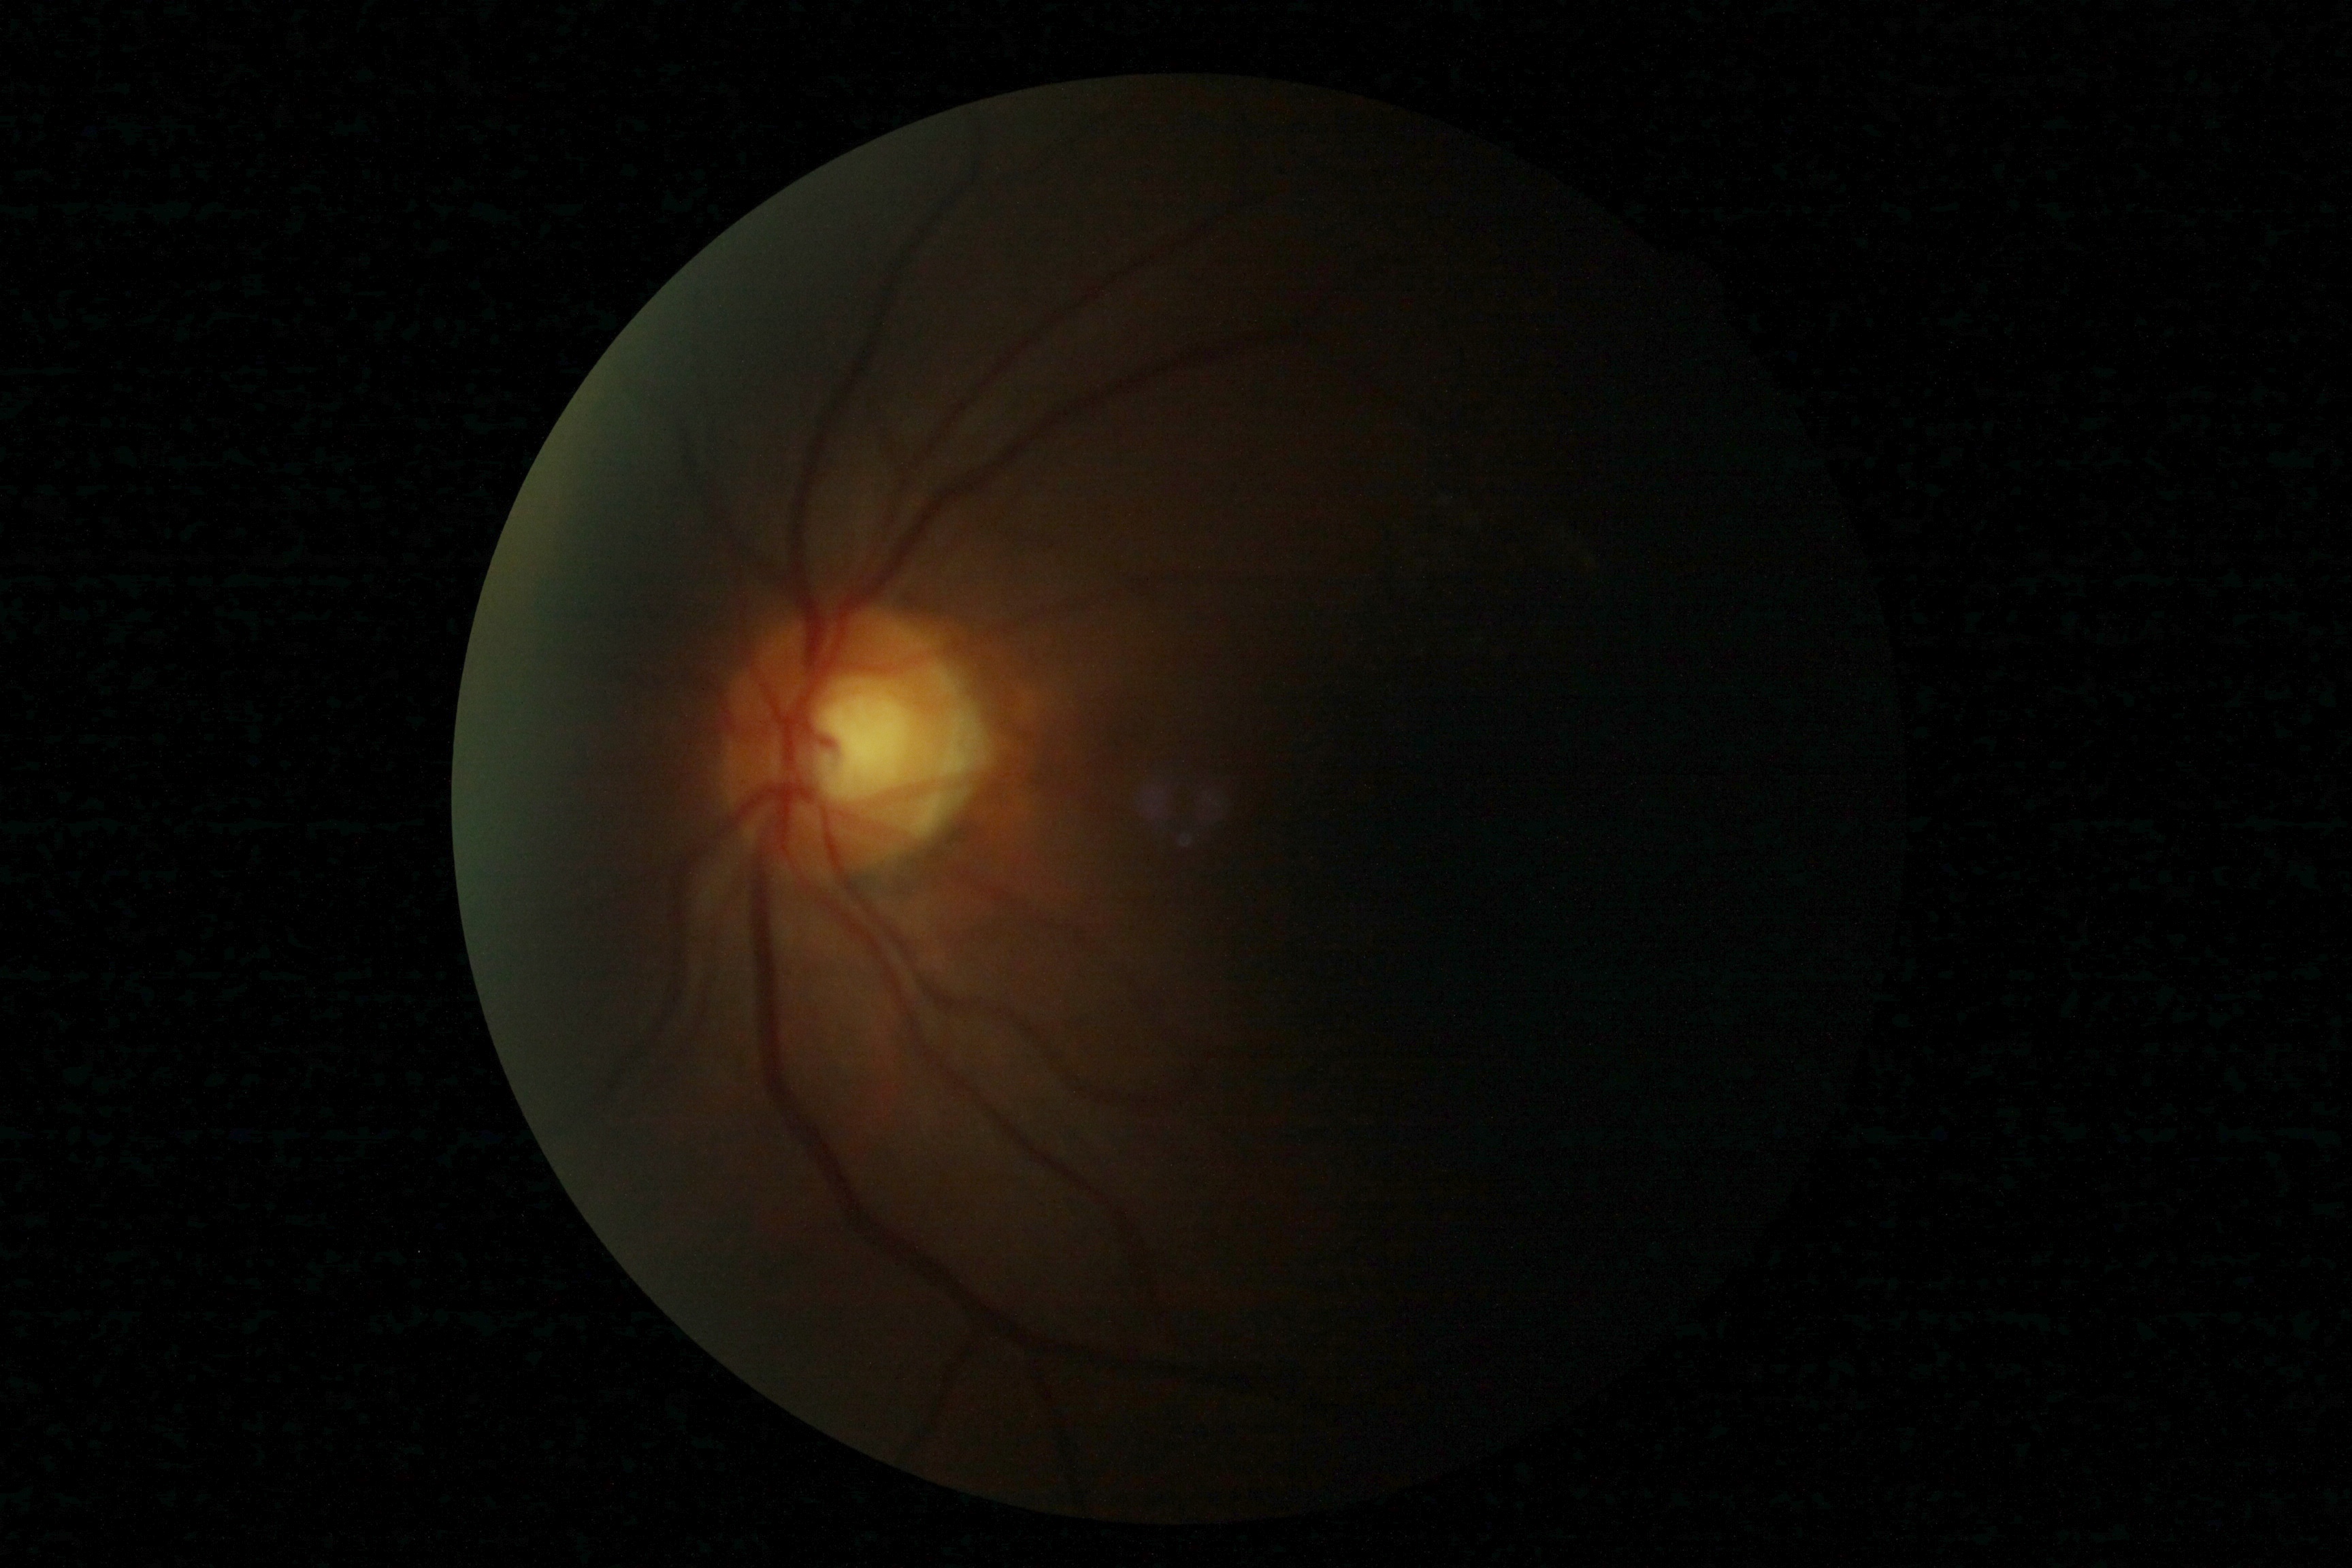

diabetic retinopathy (DR): ungradable | image quality: too poor for DR grading.